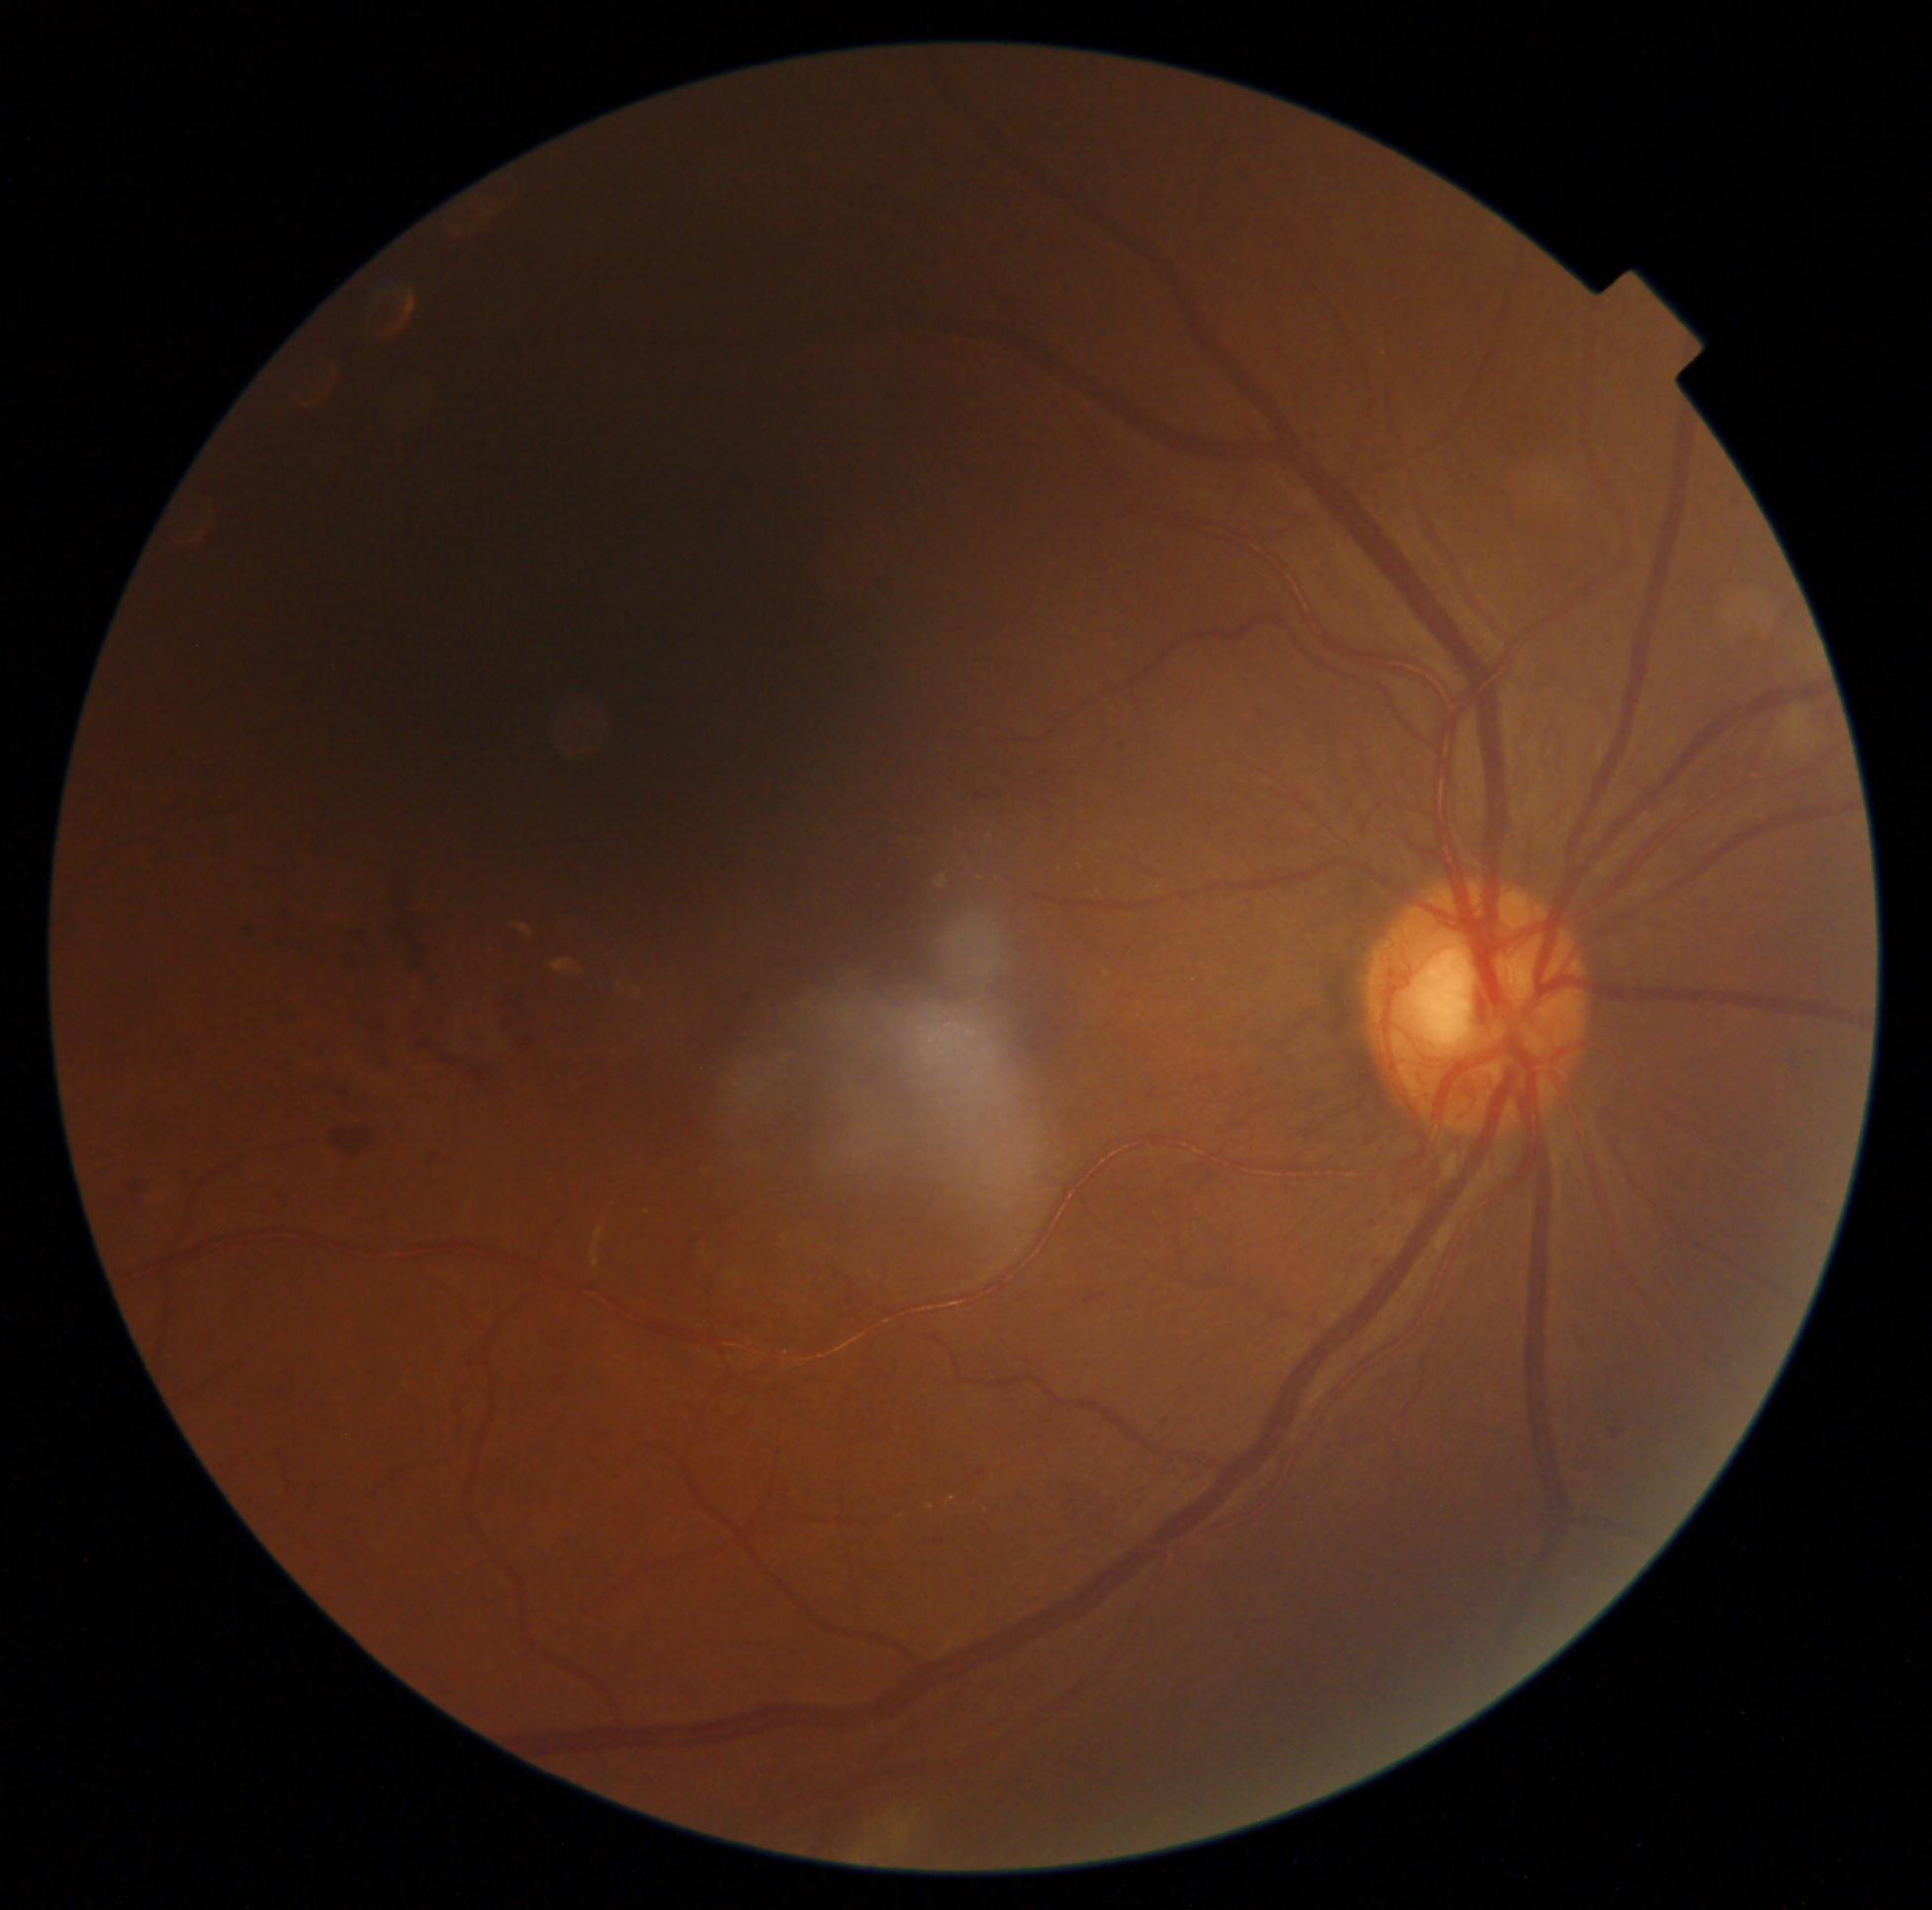 DR stage = moderate non-proliferative diabetic retinopathy (grade 2) — more than just microaneurysms but less than severe NPDR.